Pupil-dilated; captured on a Kowa VX-10α fundus camera; macula-centered field.
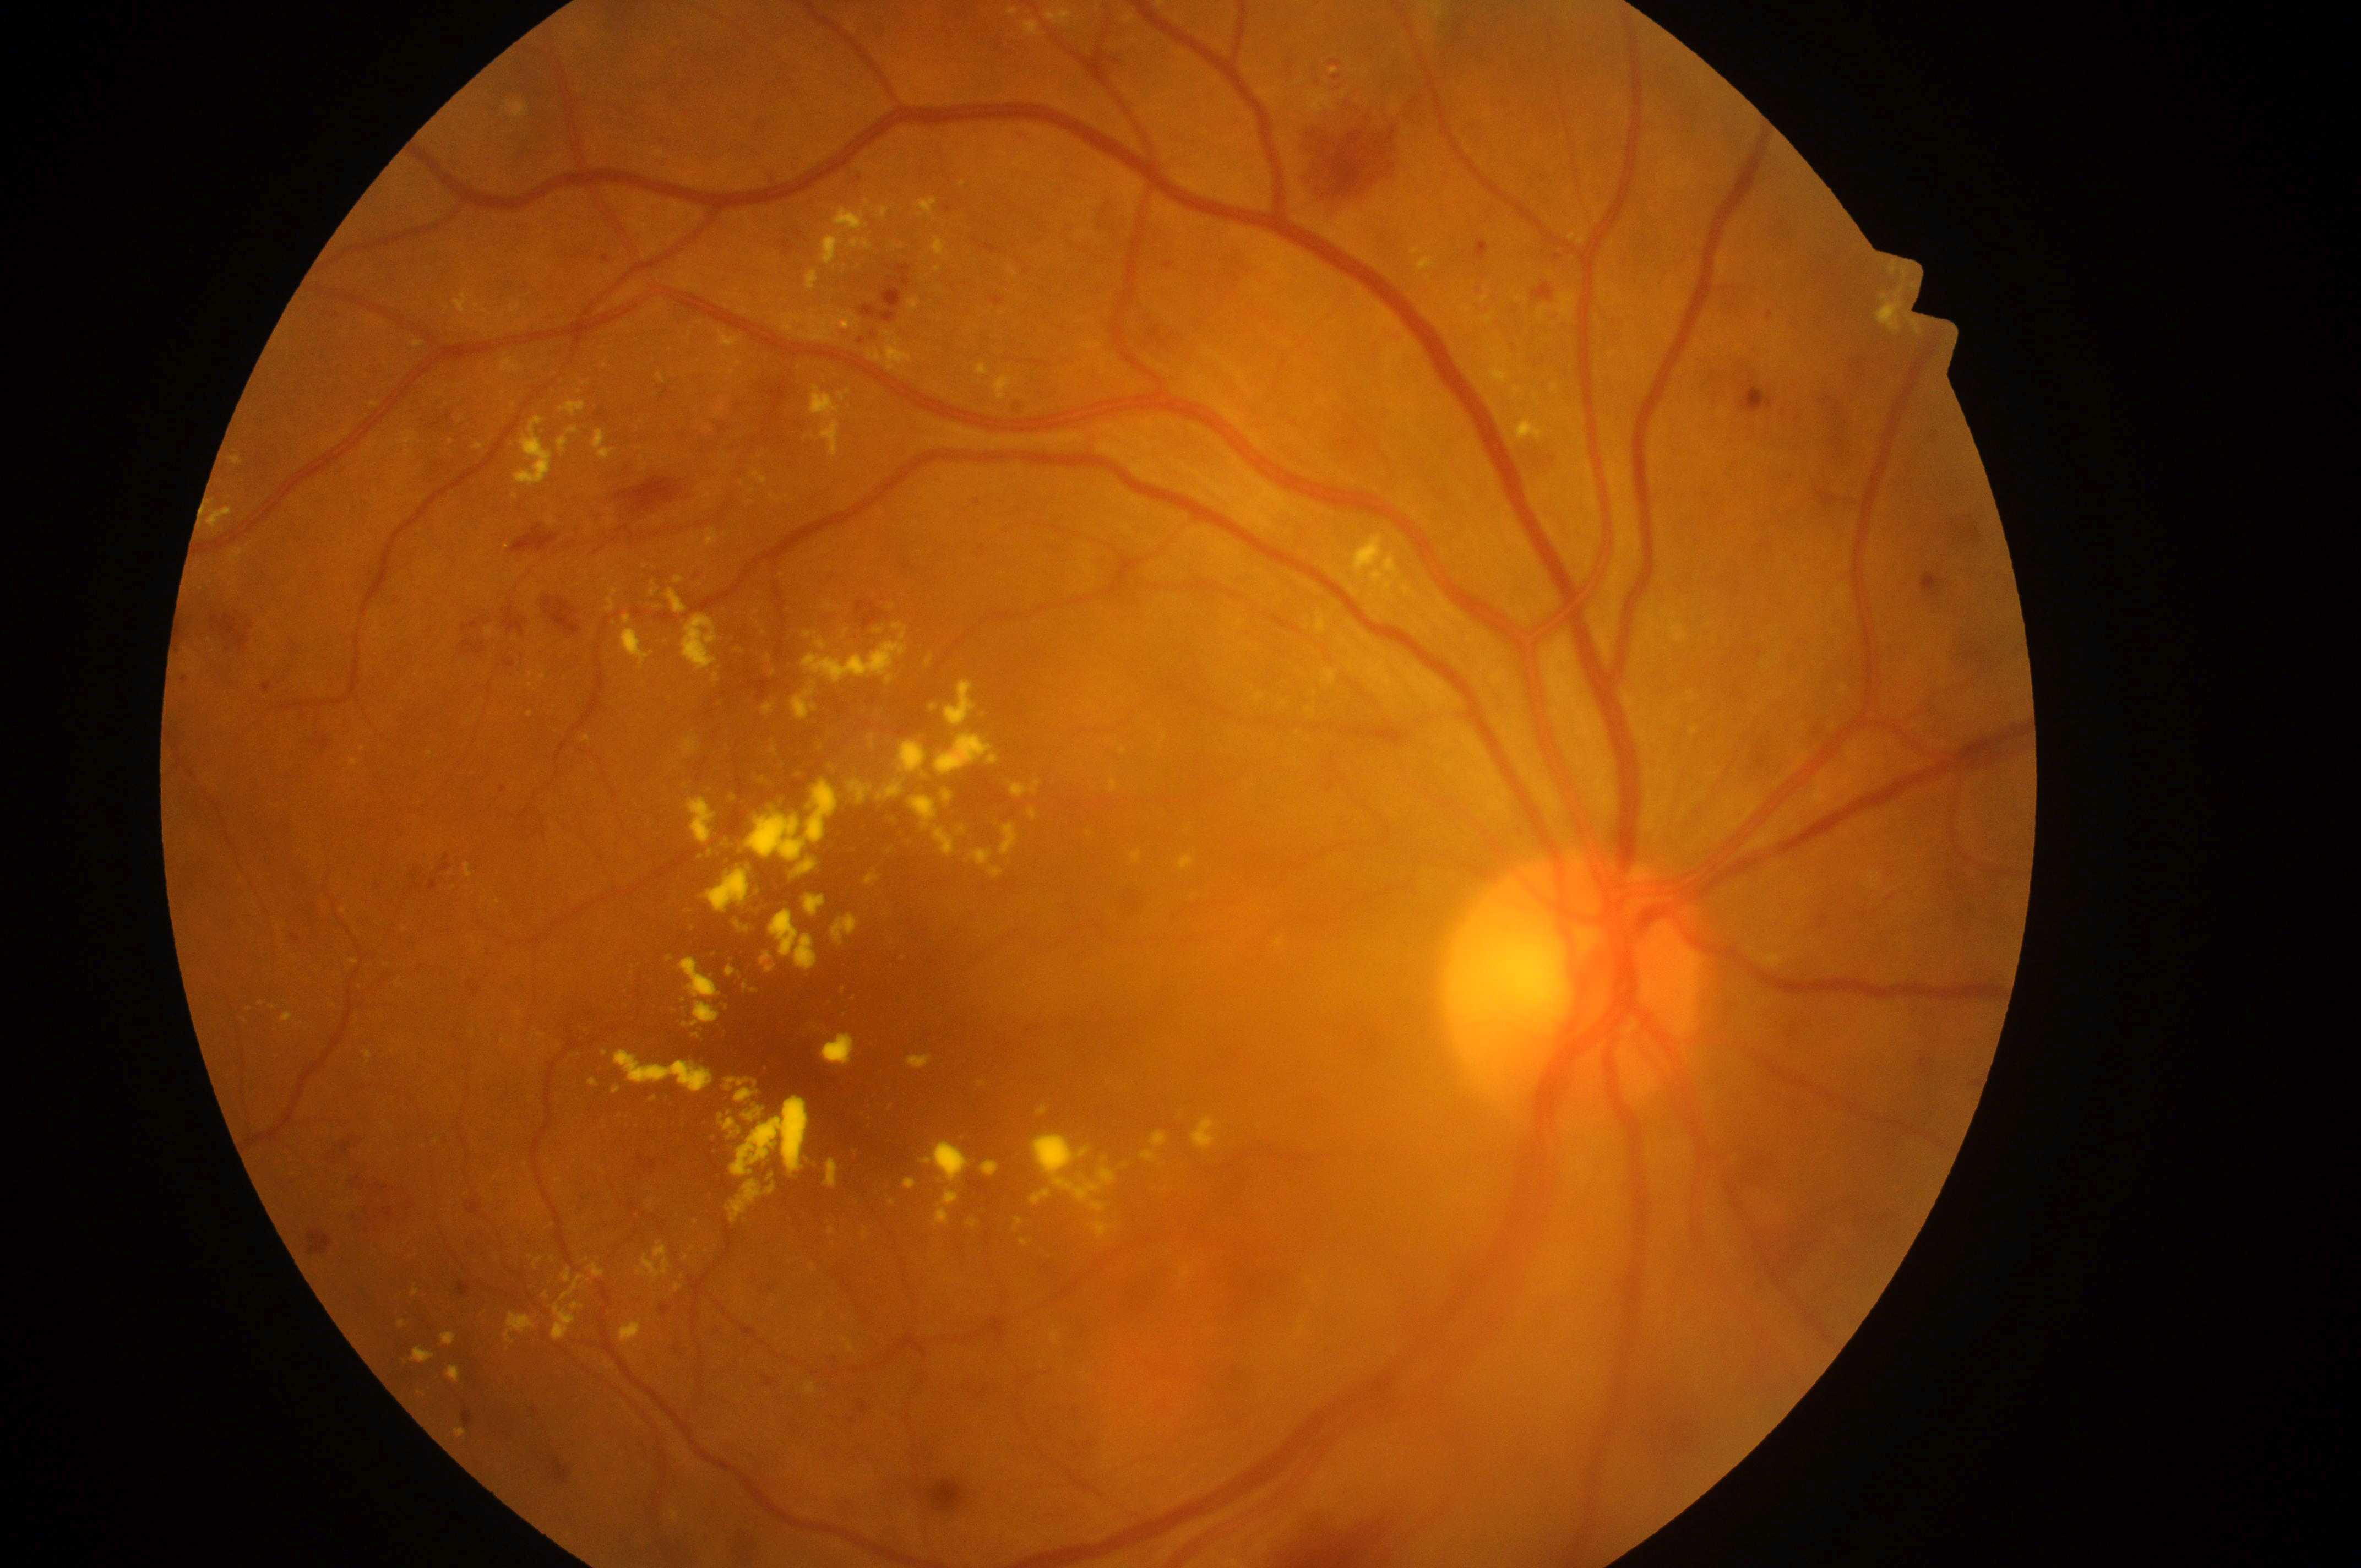

fovea@823px, 1085px; optic disk@1574px, 994px; risk of macular edema@high risk (grade 2); oculus dexter; retinopathy grade@3 (severe NPDR).